Non-mydriatic.
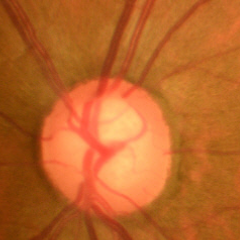 No glaucomatous optic neuropathy.